Infant wide-field retinal image. Camera: Phoenix ICON (100° FOV). Image size 1240x1240:
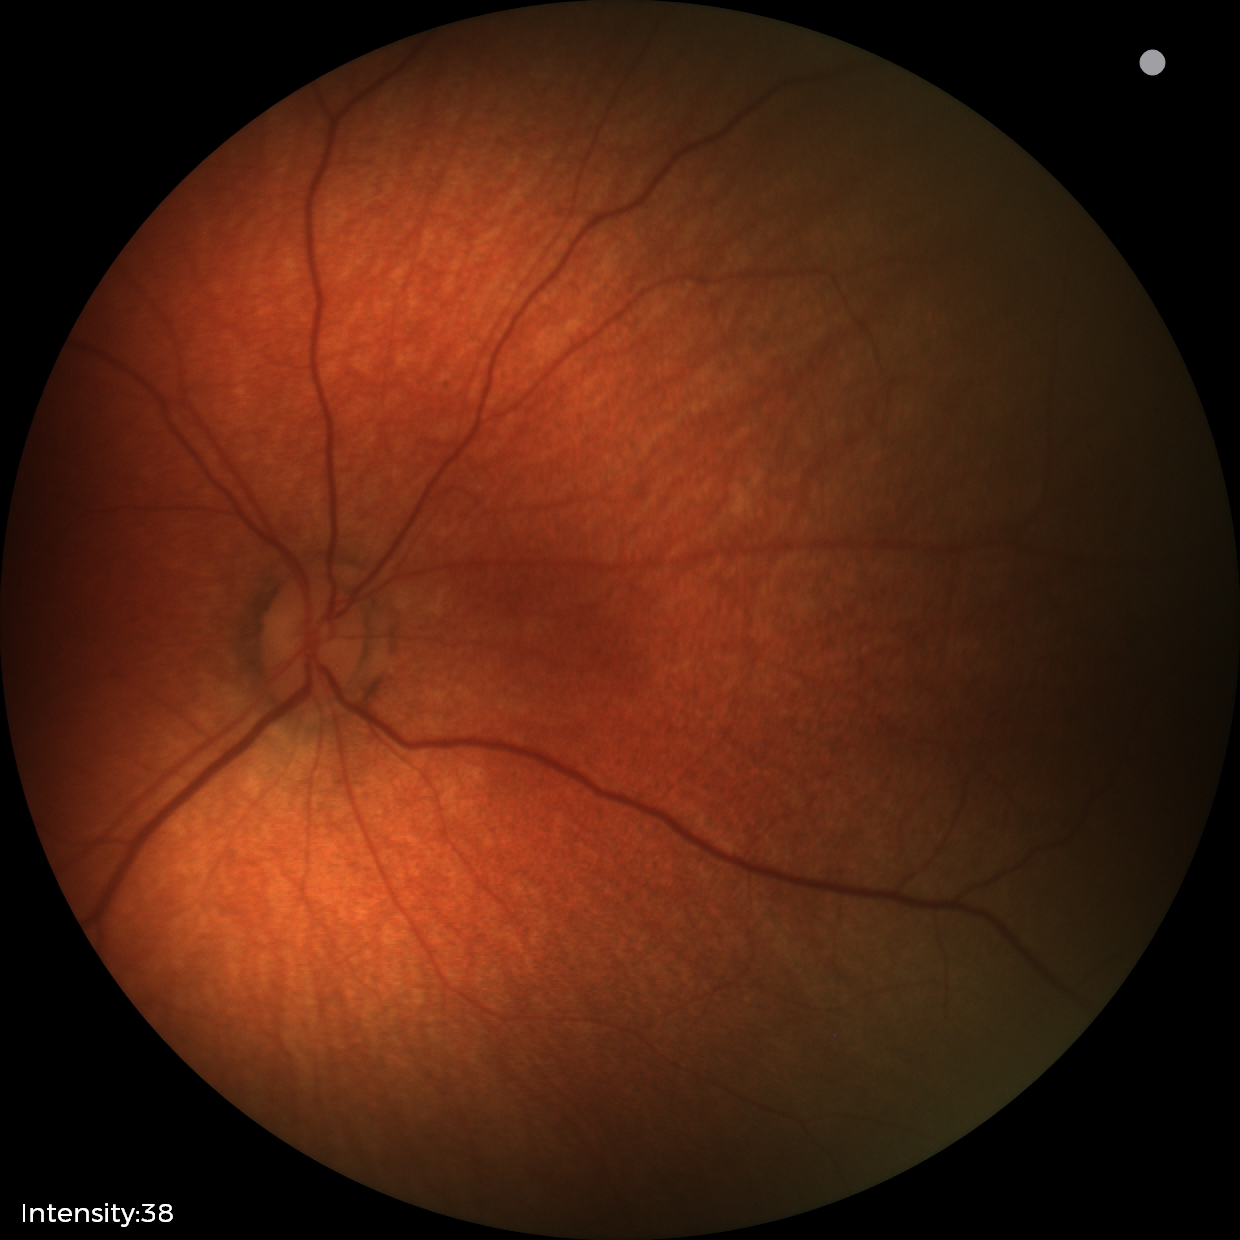 Examination with physiological retinal findings.